45° field of view; CFP
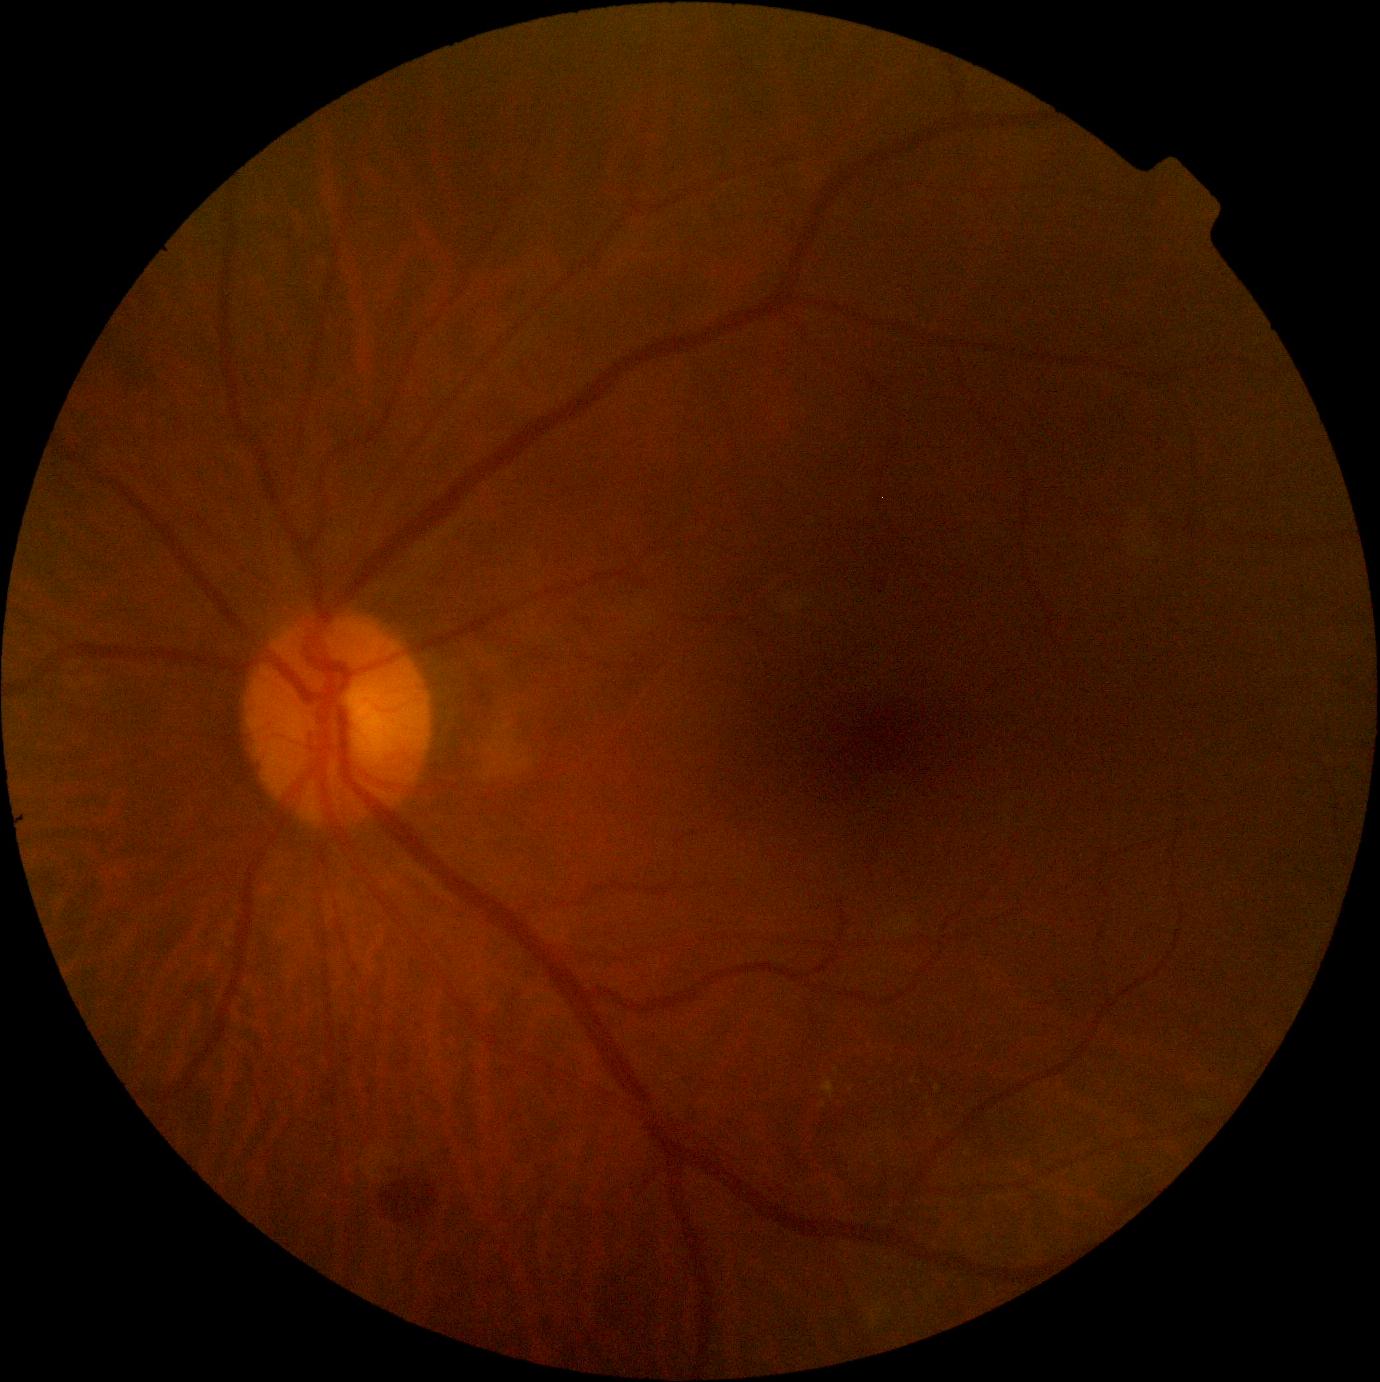

dr_grade: grade 2 (moderate NPDR)